45° FOV. CFP
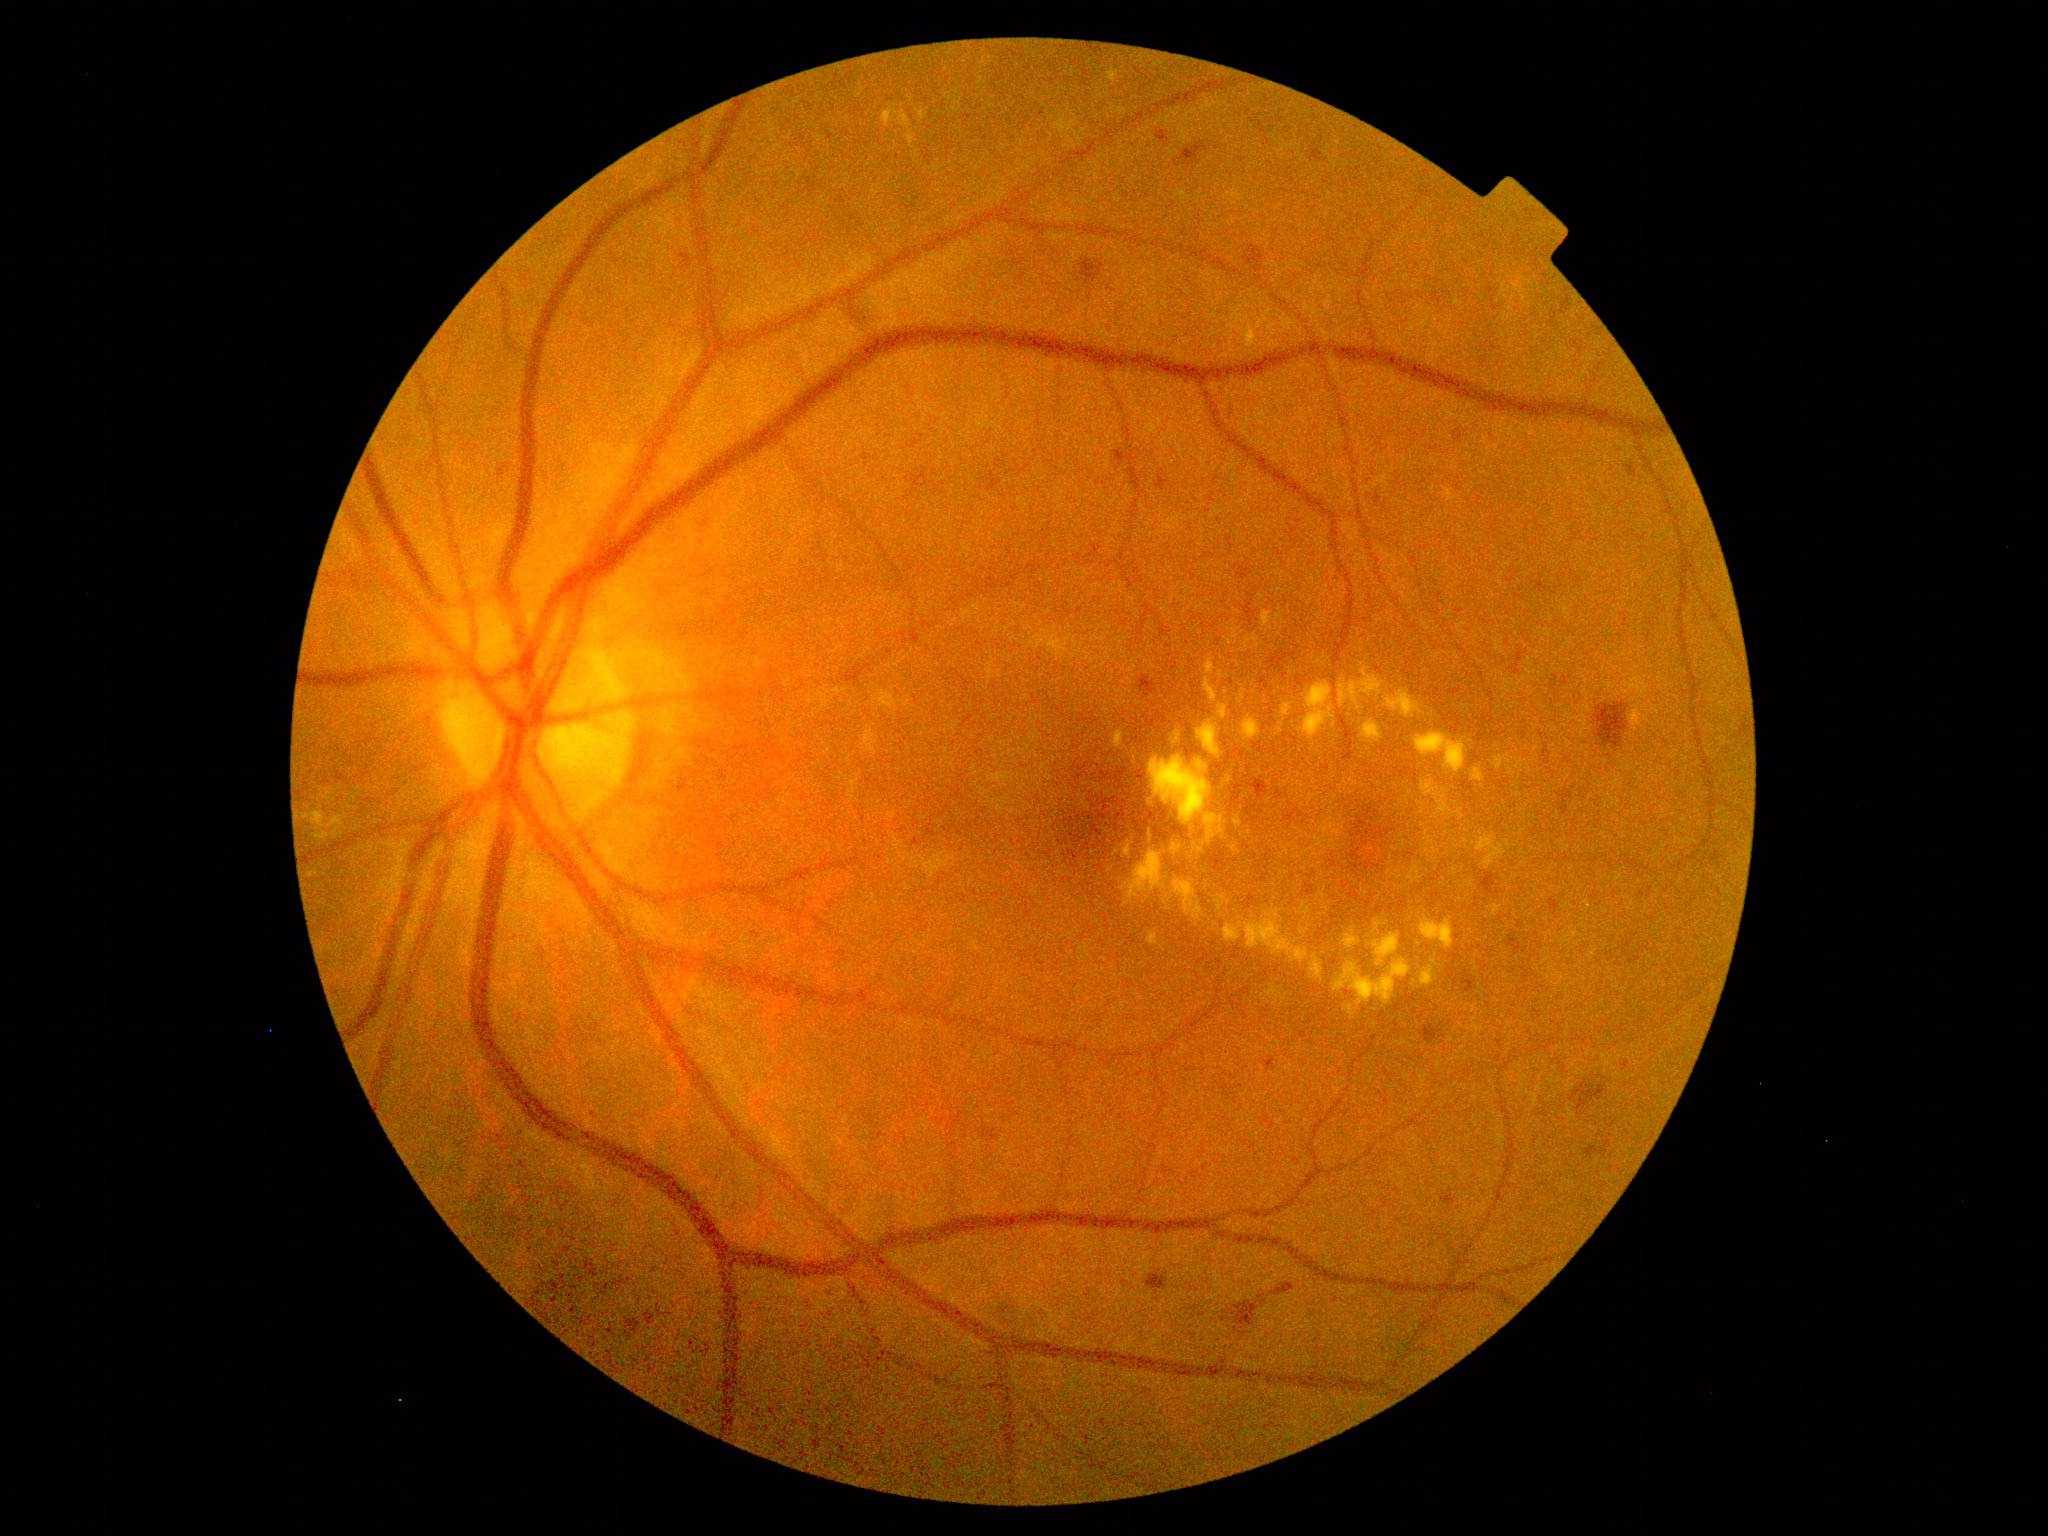
Diabetic retinopathy (DR): 2/4
A subset of detected lesions:
• hard exudates (EXs) (more not shown): 1238,687,1247,705 | 1471,767,1486,783 | 1297,829,1304,842 | 1165,985,1172,995 | 1418,802,1426,808 | 1360,720,1384,746 | 1384,689,1424,719 | 863,727,878,755 | 1121,851,1205,921 | 1454,868,1457,876
• EXs (small, approximate centers) near [x=1505, y=697] | [x=1127, y=974] | [x=1419, y=944] | [x=1282, y=807] | [x=1322, y=915] | [x=1114, y=672] | [x=1226, y=692] | [x=1466, y=840] | [x=1441, y=1002]
• hemorrhages (HEs) (more not shown): 1072,819,1076,828 | 1143,712,1168,729 | 1595,703,1629,749 | 1268,650,1297,680 | 1075,775,1085,782 | 1507,932,1522,955 | 1141,676,1156,697 | 626,1320,642,1335 | 1305,884,1315,896 | 1155,828,1171,842 | 560,1276,567,1290 | 1364,808,1378,821 | 1156,132,1169,144 | 1585,1139,1612,1159 | 1231,785,1245,812
• HEs (small, approximate centers) near [x=1096, y=767] | [x=1353, y=835] | [x=1134, y=814]